100° field of view (Phoenix ICON). 1240x1240. Wide-field fundus image from infant ROP screening — 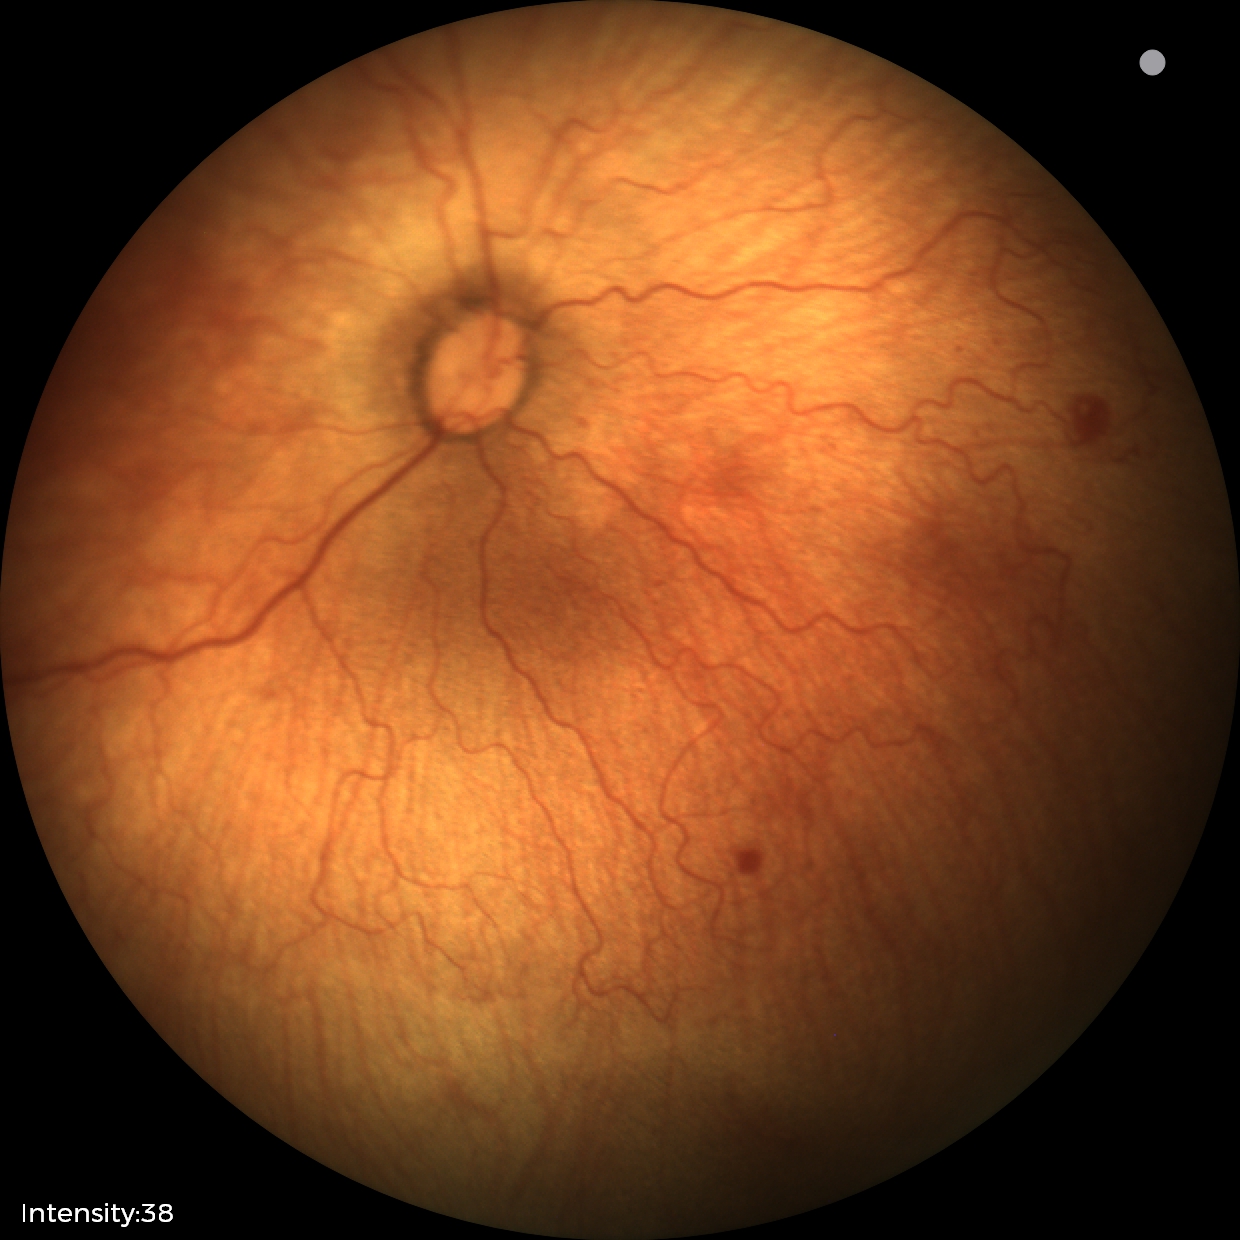
Q: What is the diagnosis from this examination?
A: retinopathy of prematurity stage 1
Q: Plus disease status?
A: no plus disease